848x848px · without pupil dilation · Davis DR grading:
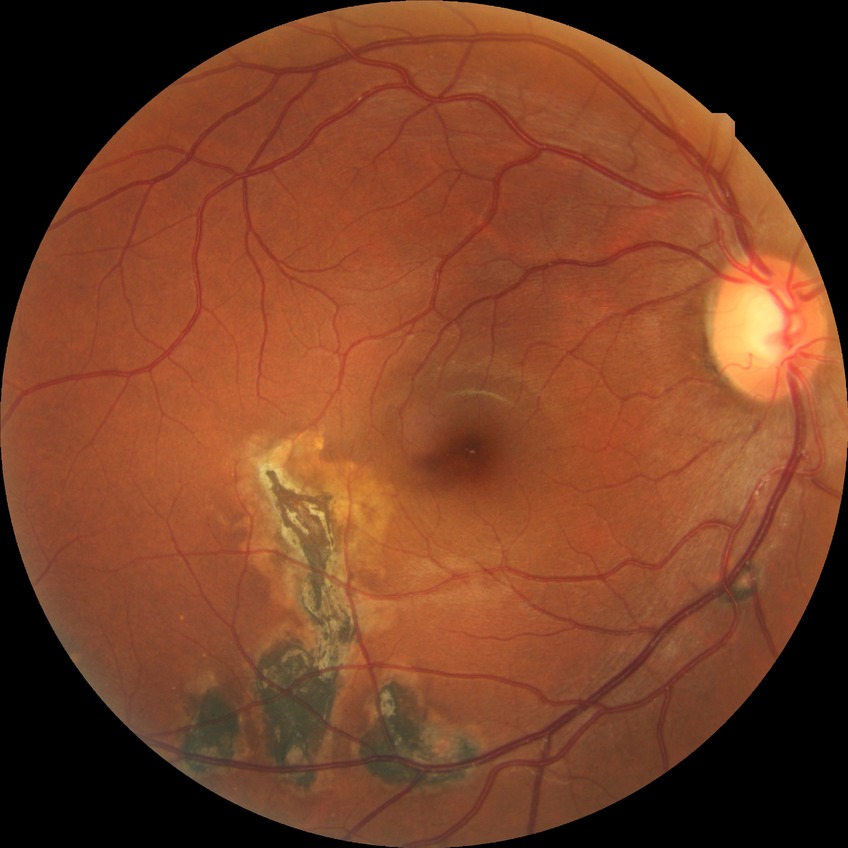
Modified Davis grade: NDR.